45 degree fundus photograph — 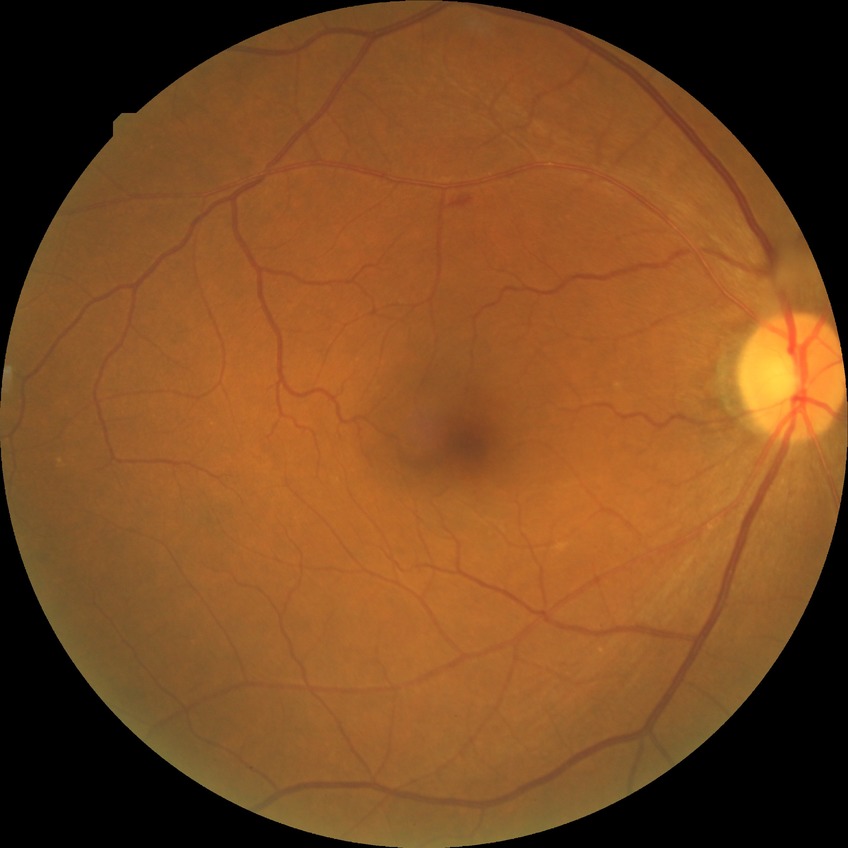 DR severity: SDR. Disease class: non-proliferative diabetic retinopathy.